45-degree field of view — 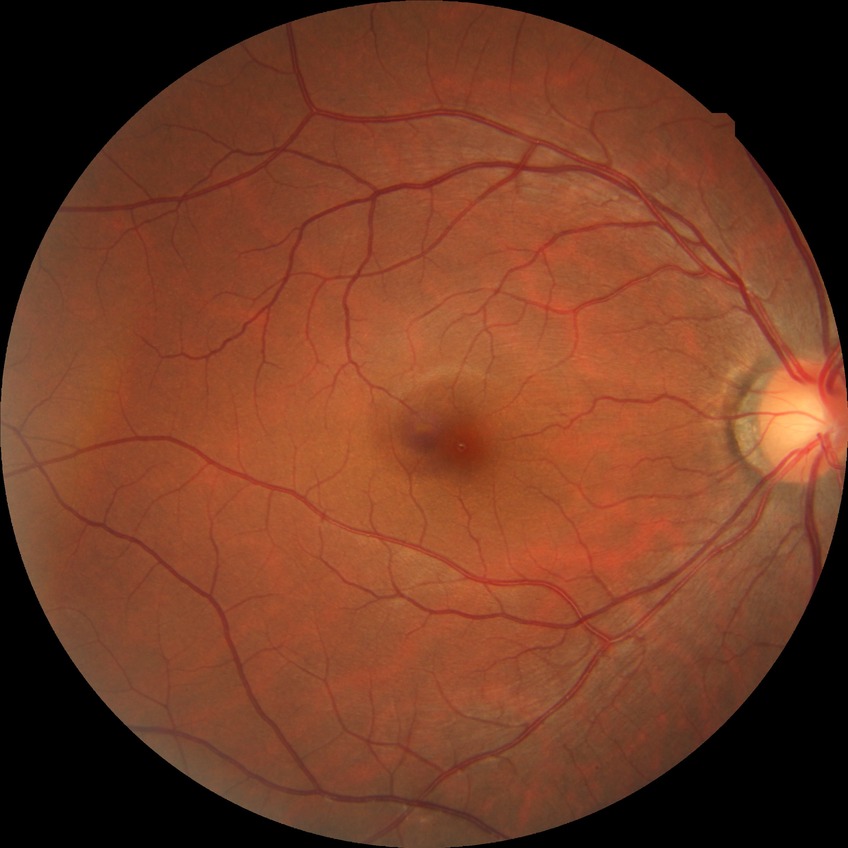 No apparent diabetic retinopathy. DR: NDR.